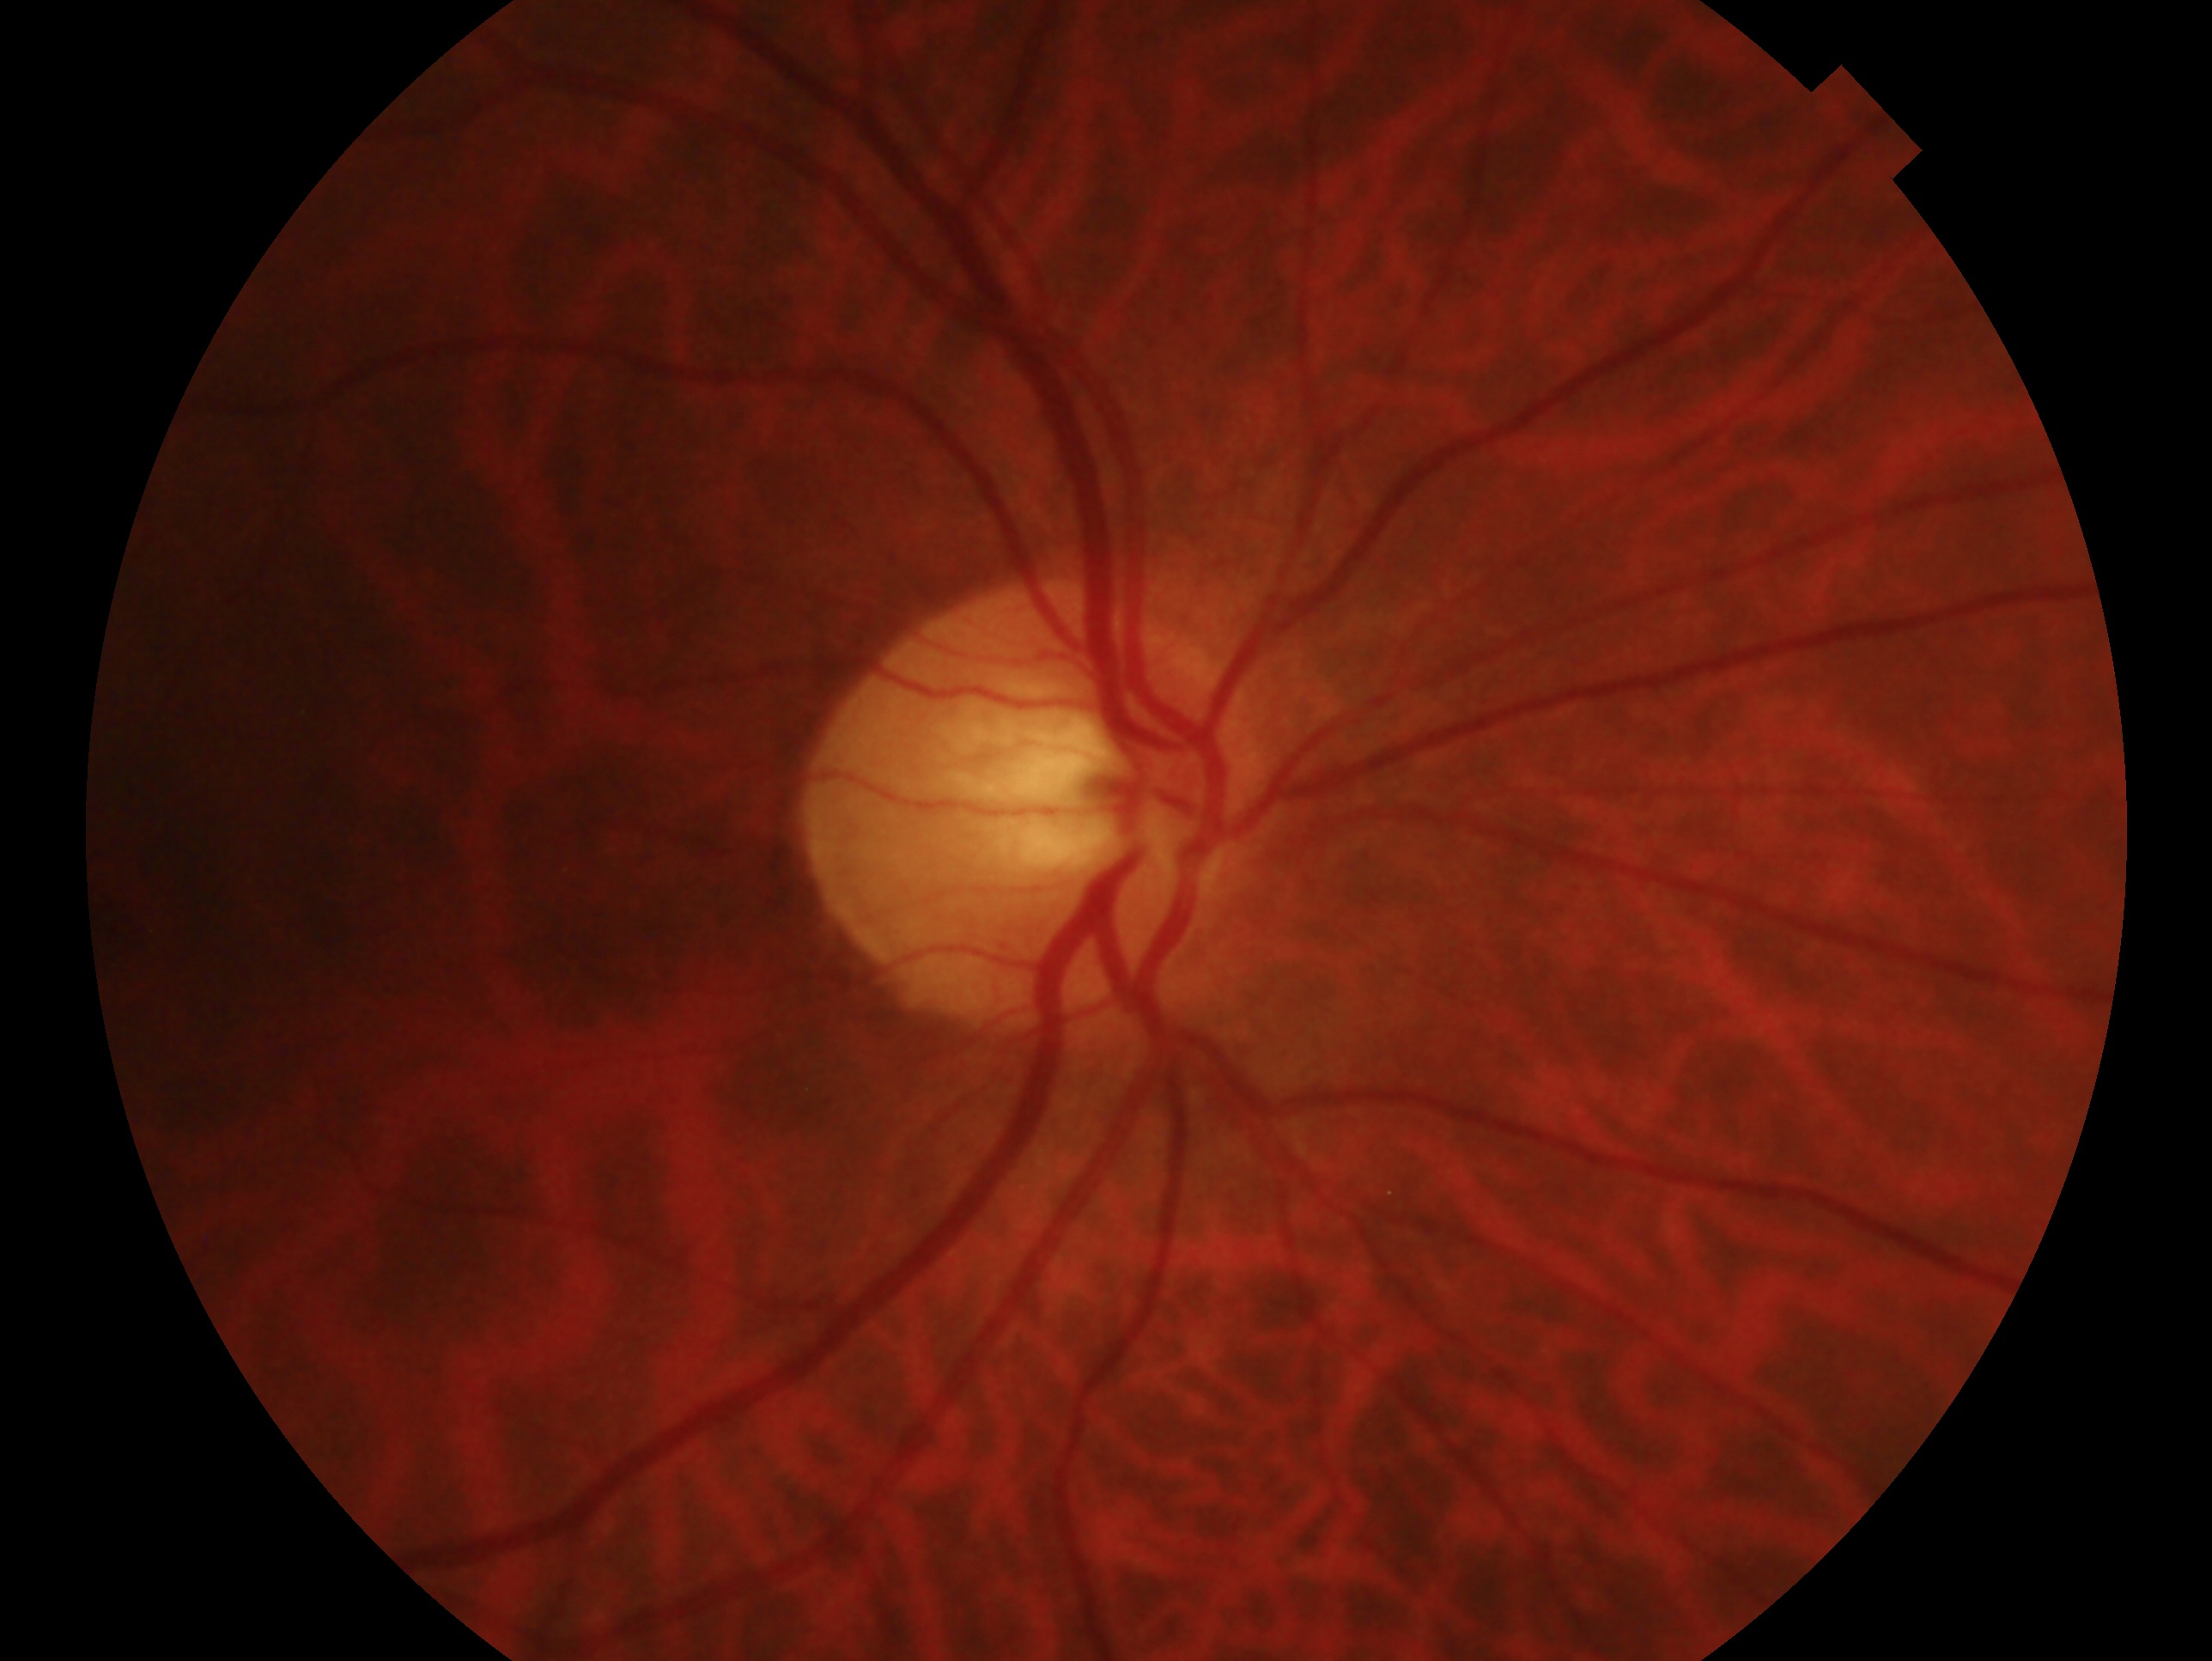

Impression: no glaucomatous findings.
Eye: right.